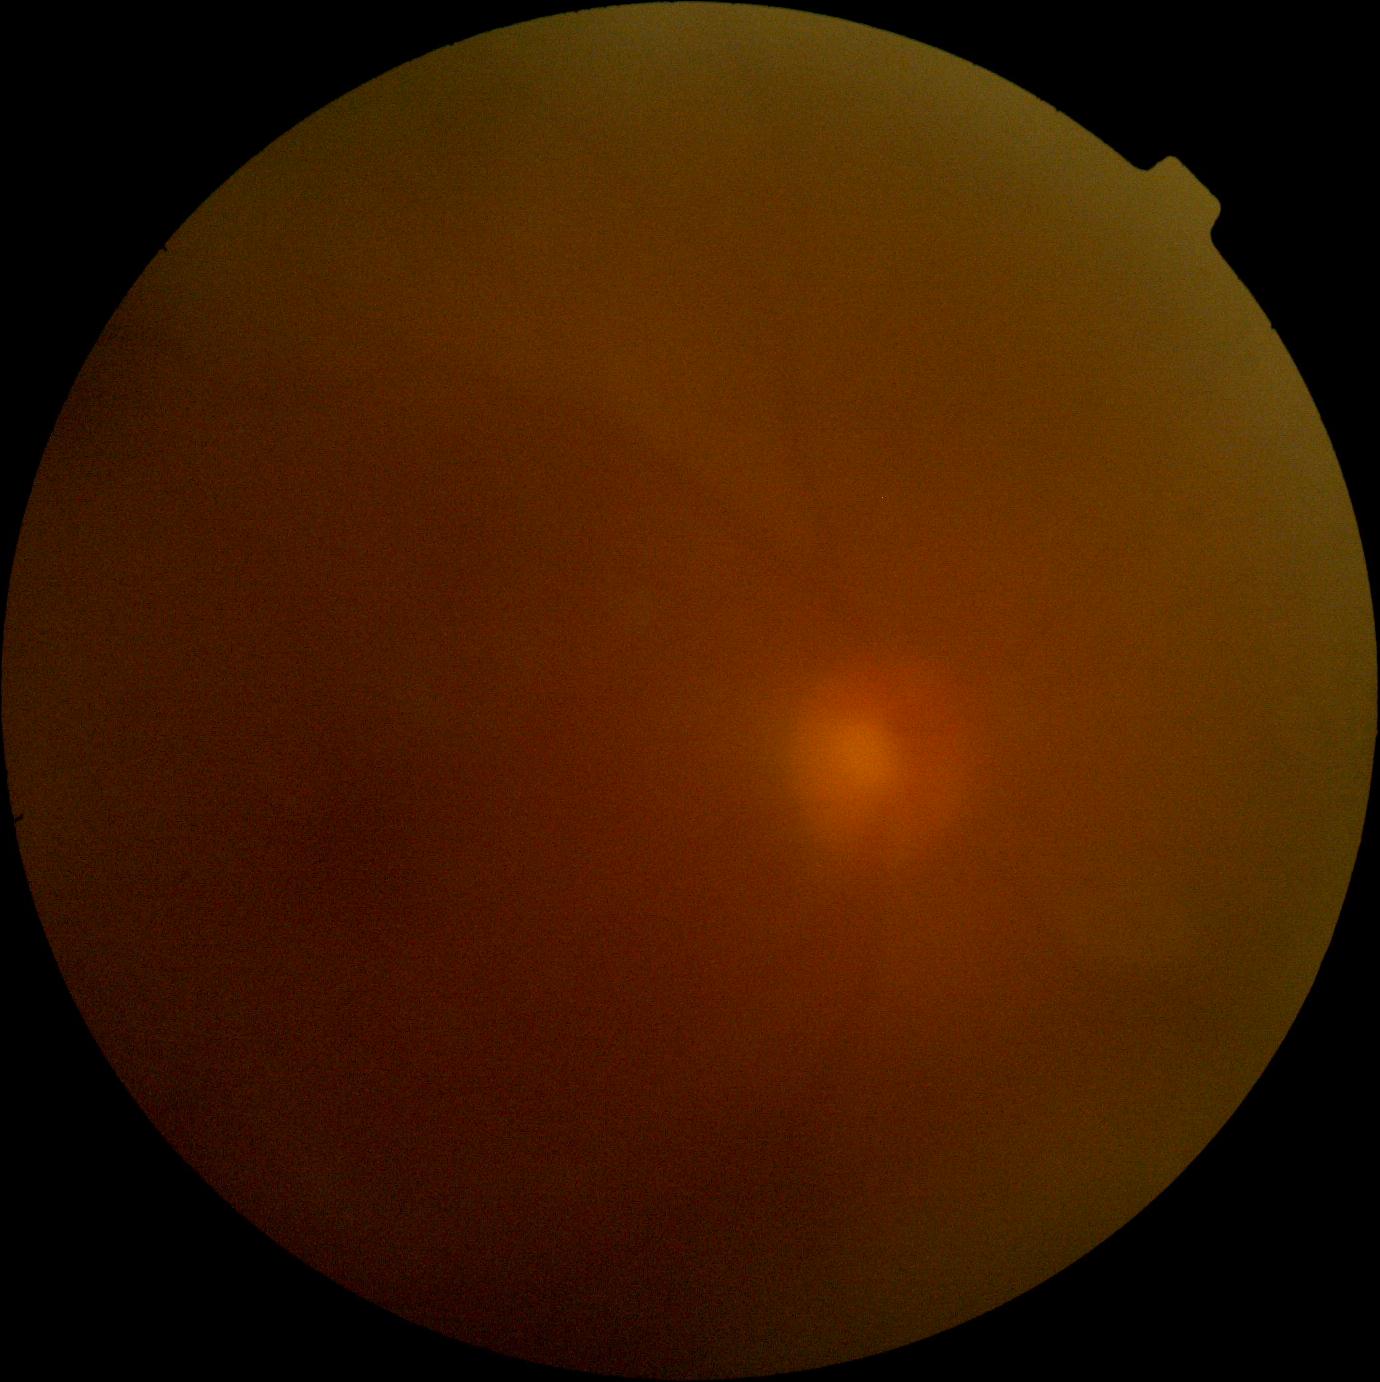
image quality = too poor for DR grading | diabetic retinopathy grade = ungradable.